Ultra-widefield fundus photograph.
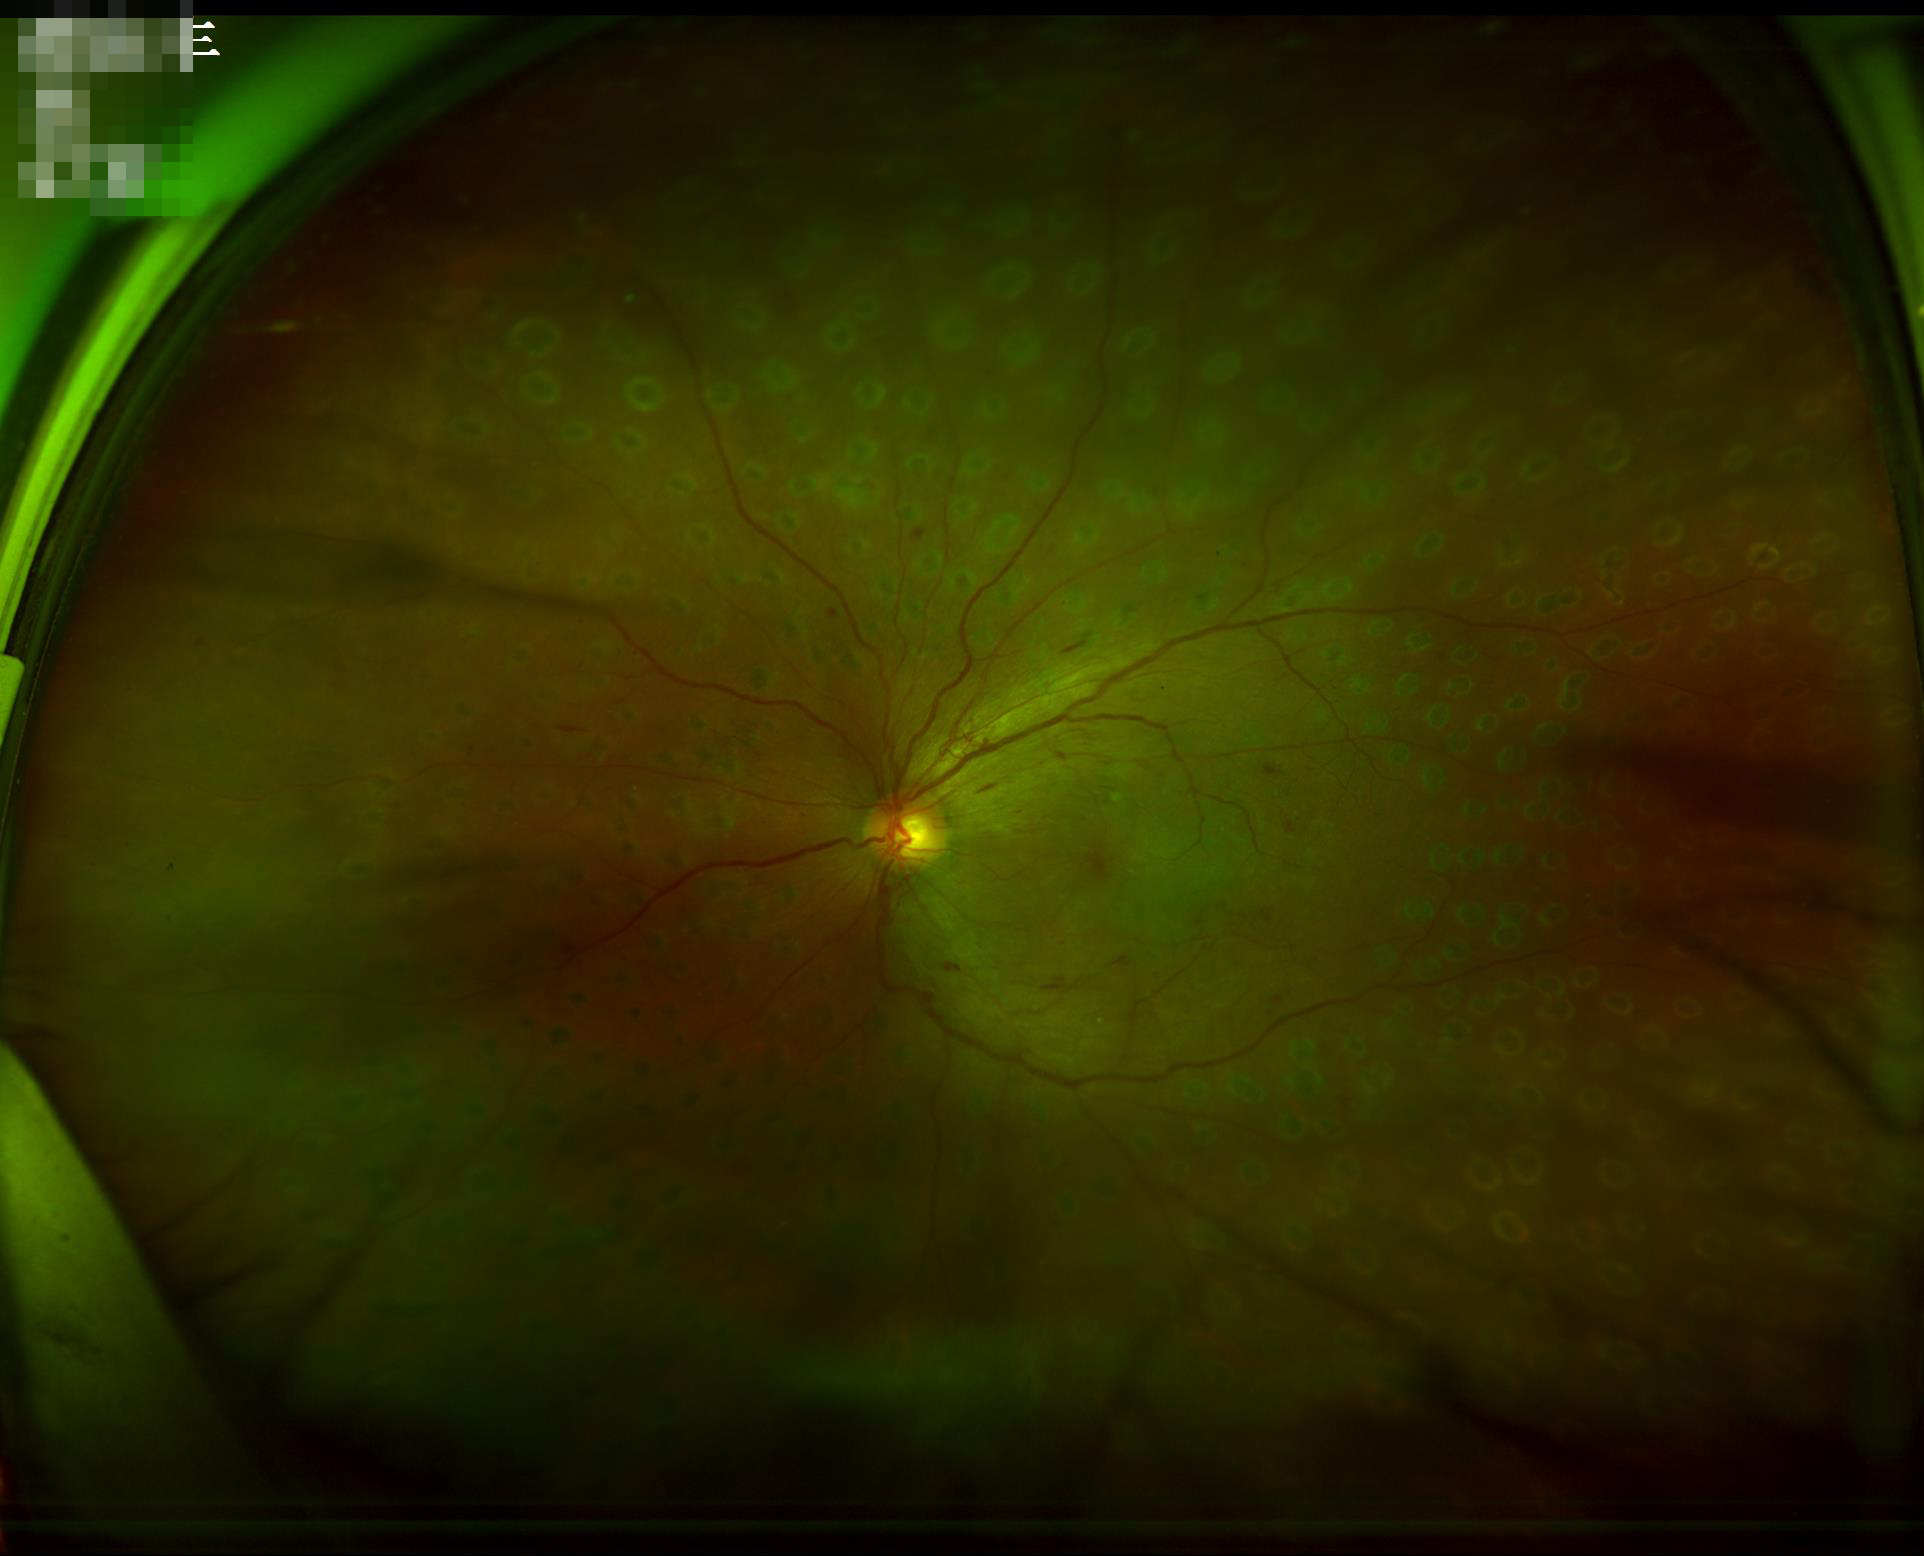

Image quality is adequate for diagnostic use.
Poor illumination with uneven exposure.
Vessels and details are readily distinguishable.